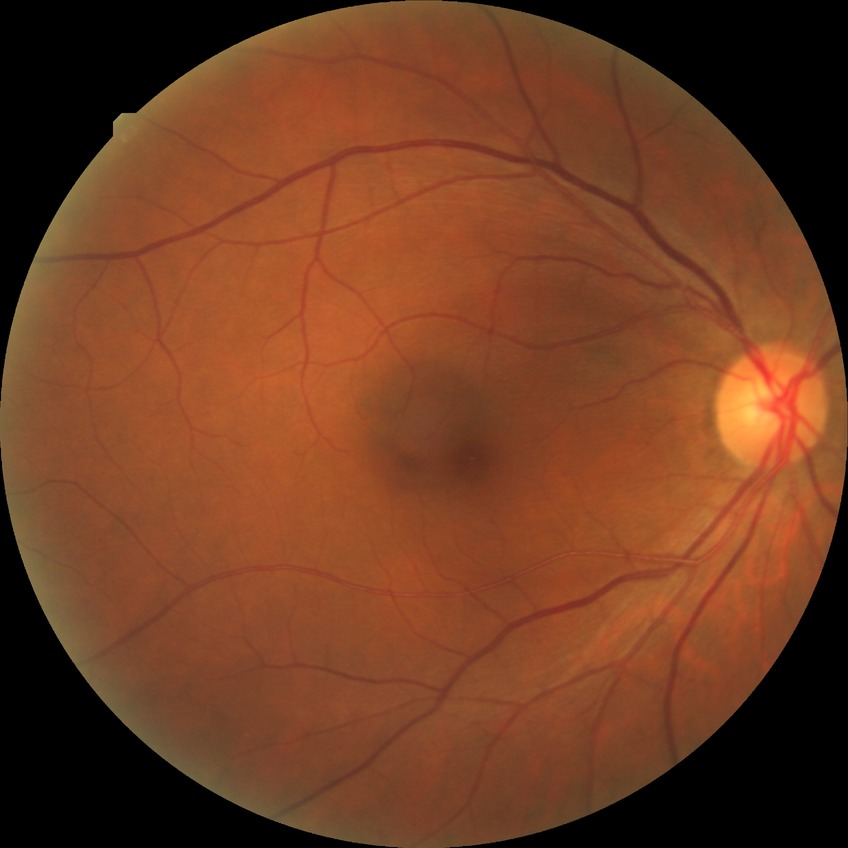

DR: NDR.